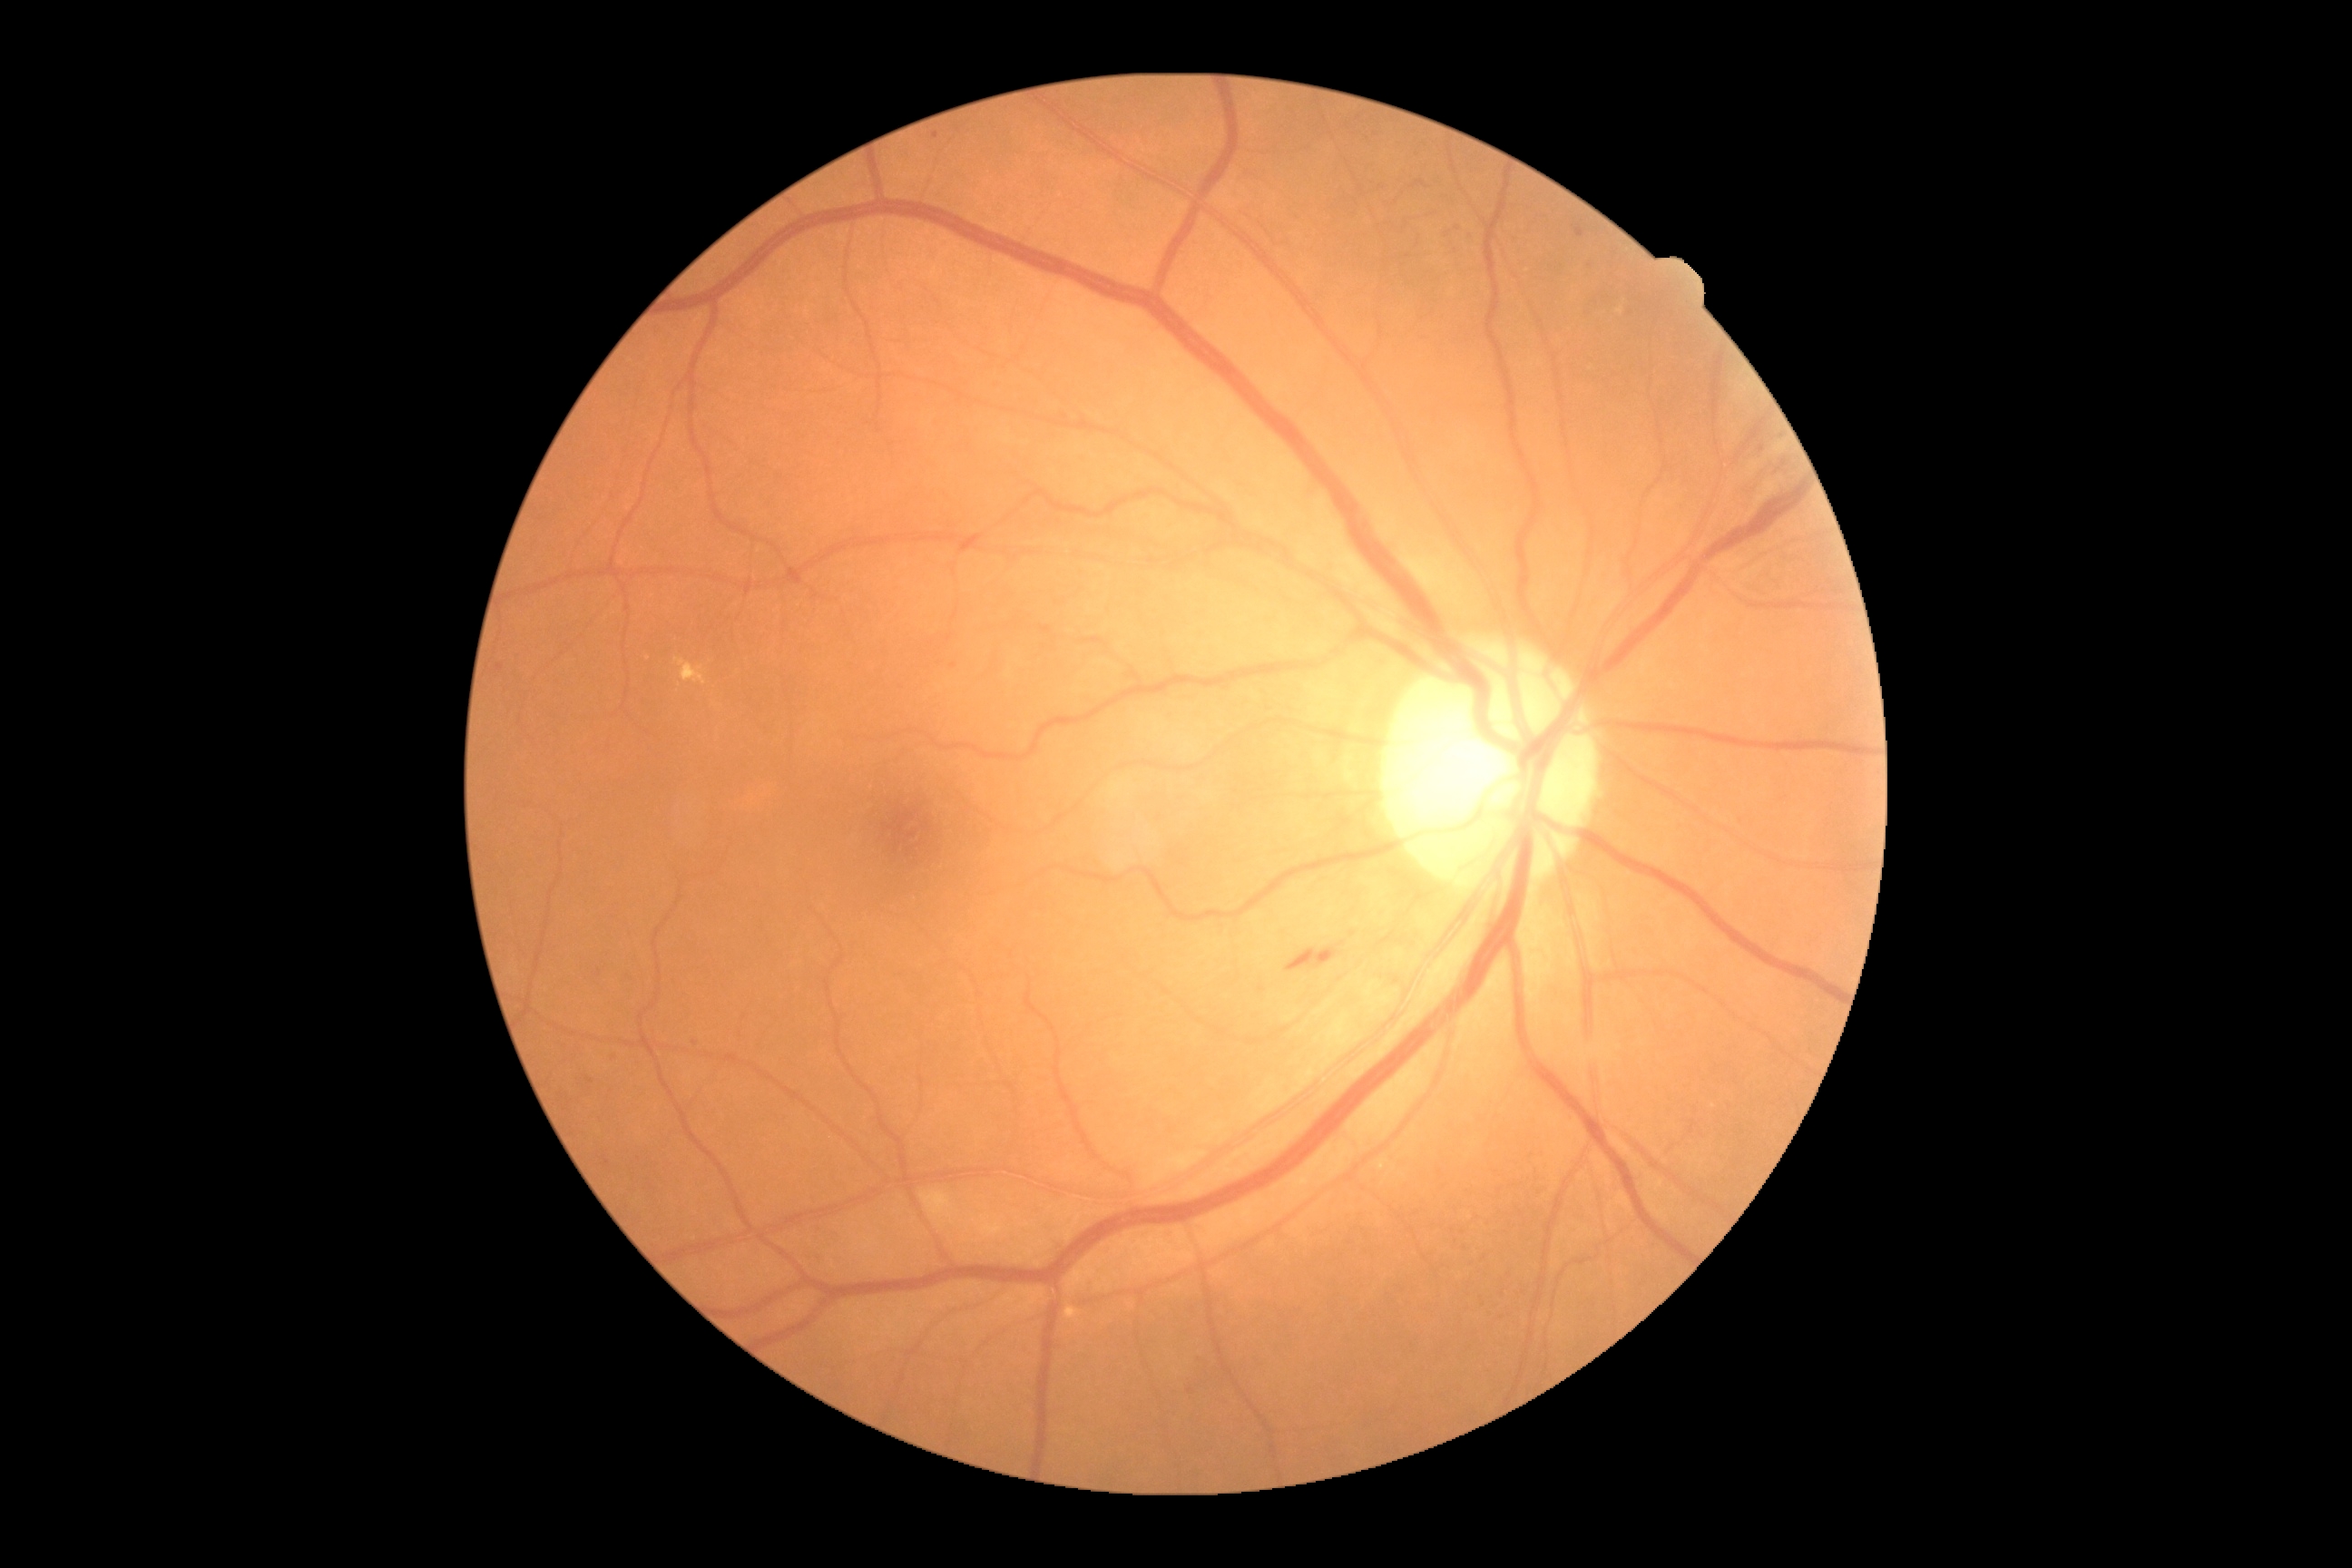   dr_grade: grade 3 (severe NPDR)